45° field of view · fundus photo · image size 2352x1568
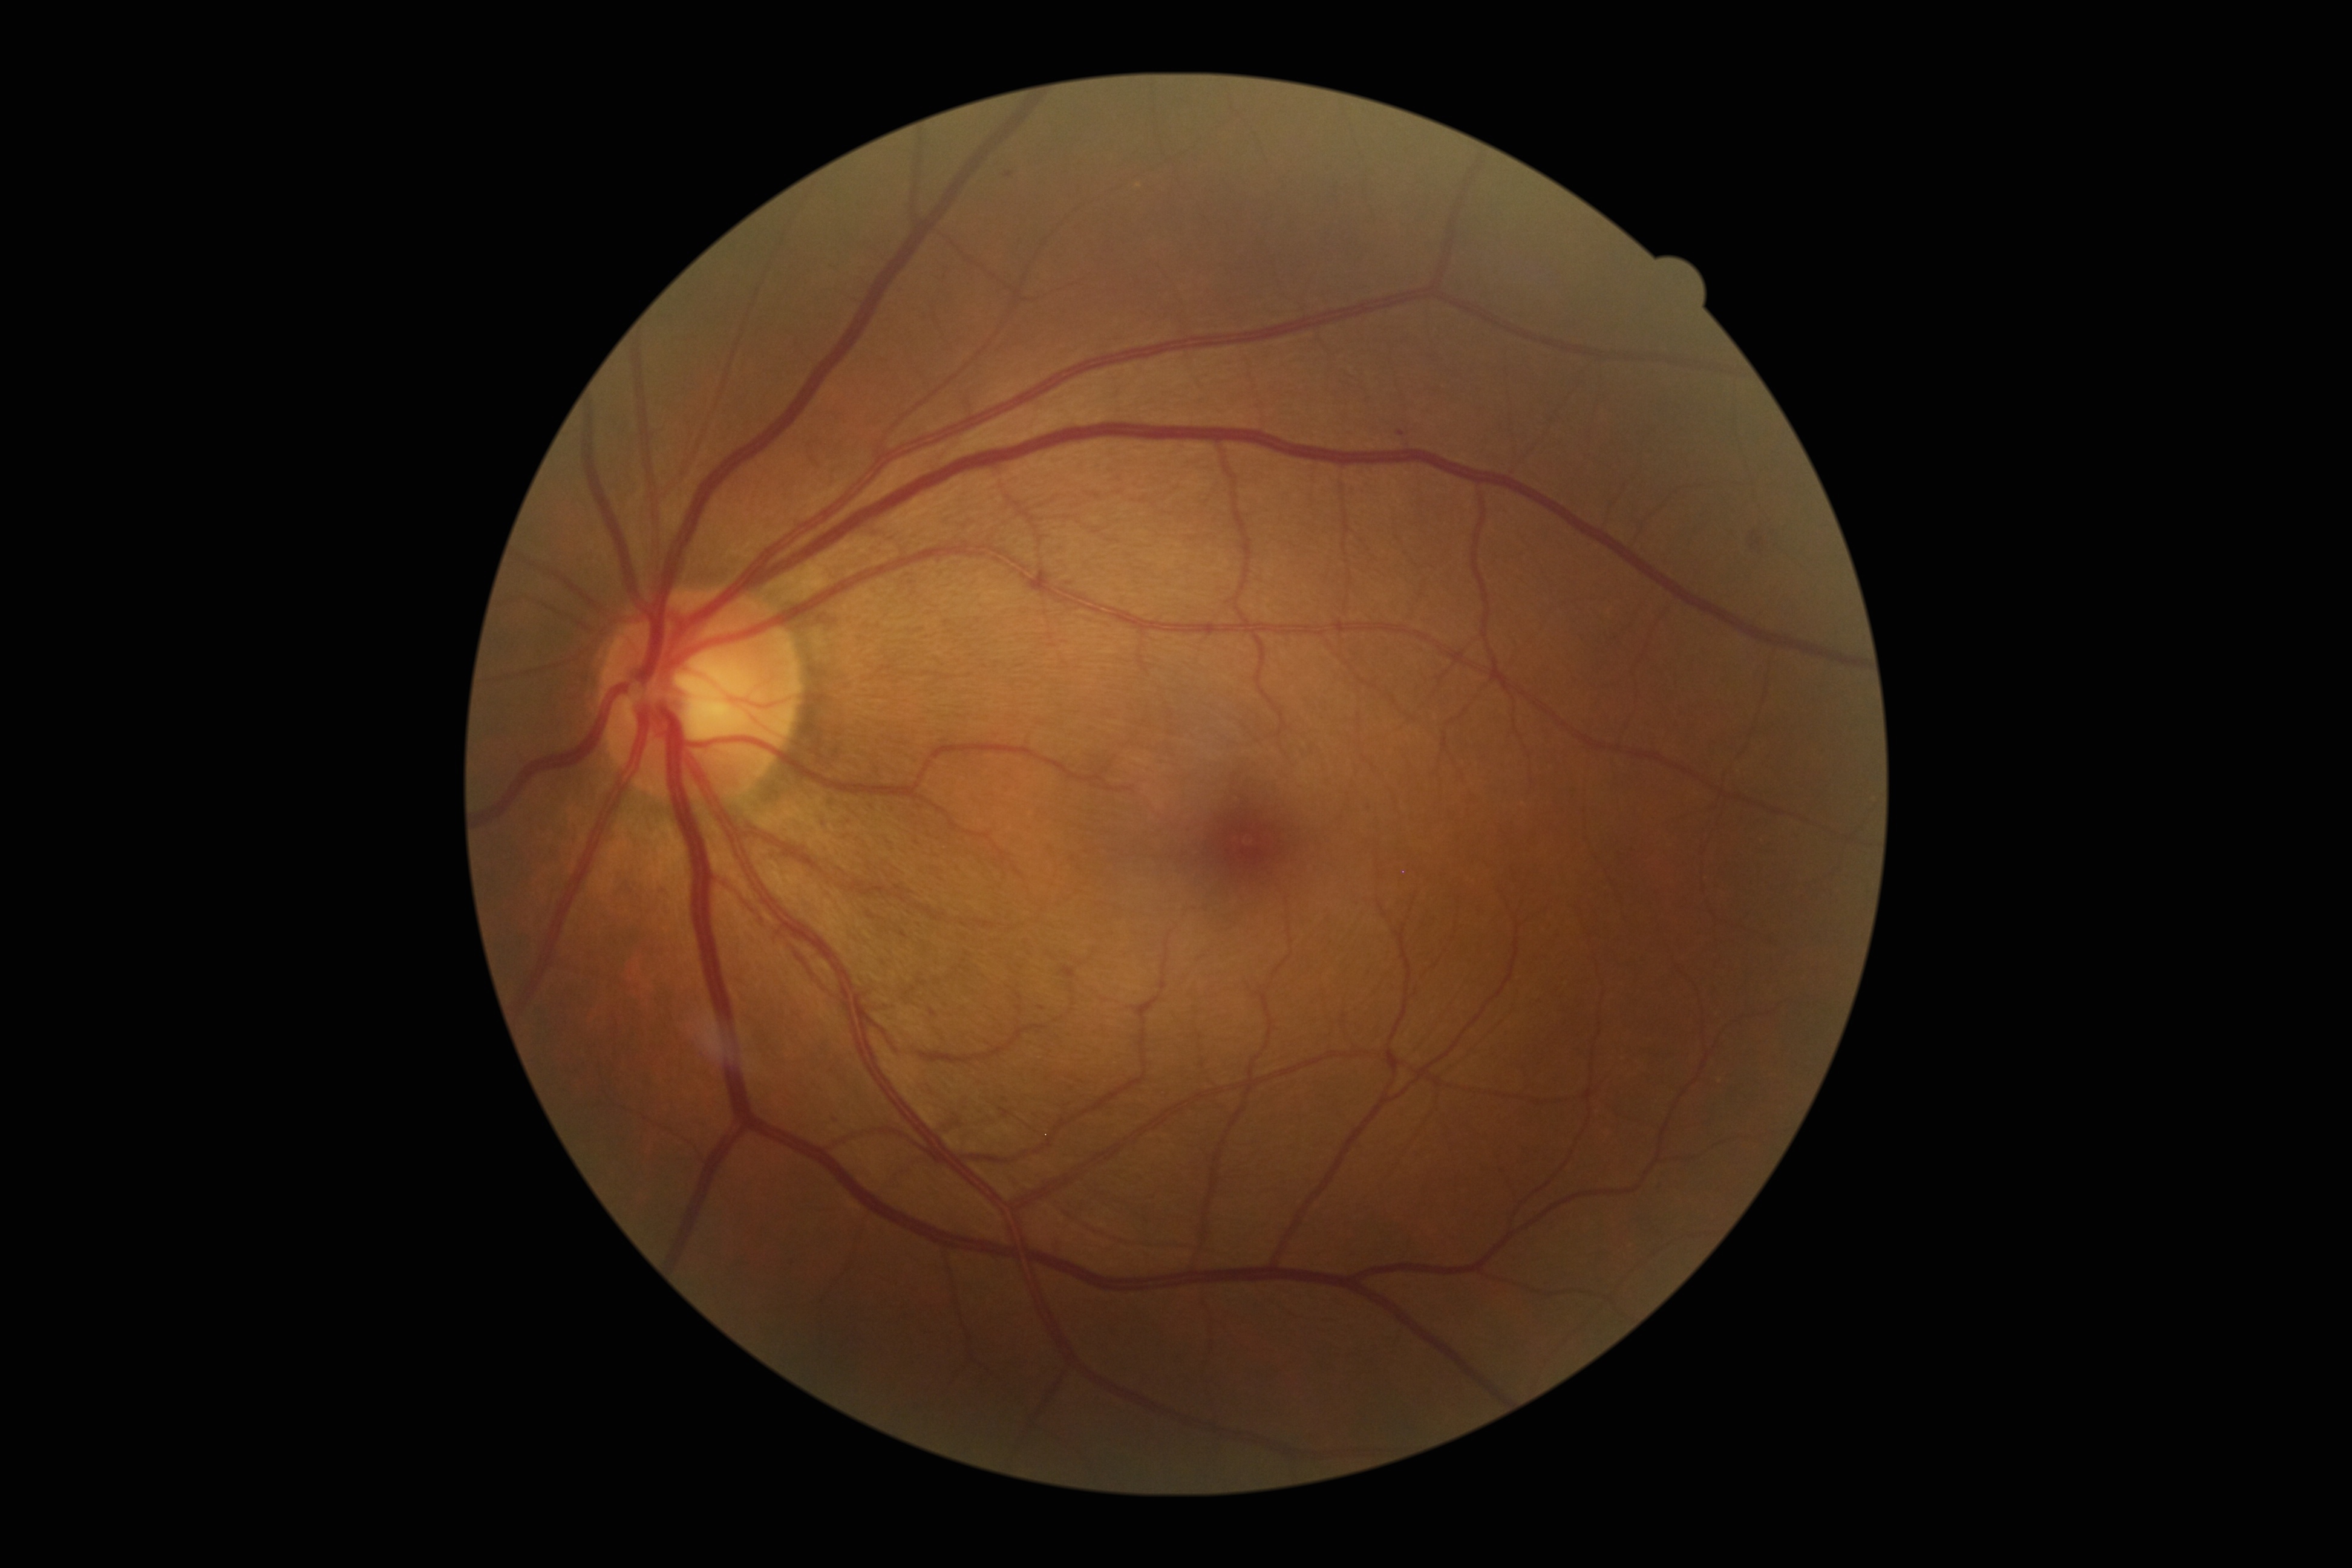
Annotations:
• DR stage: 2
• DR class: non-proliferative diabetic retinopathy